NIDEK AFC-230 · 45-degree field of view · 848 by 848 pixels
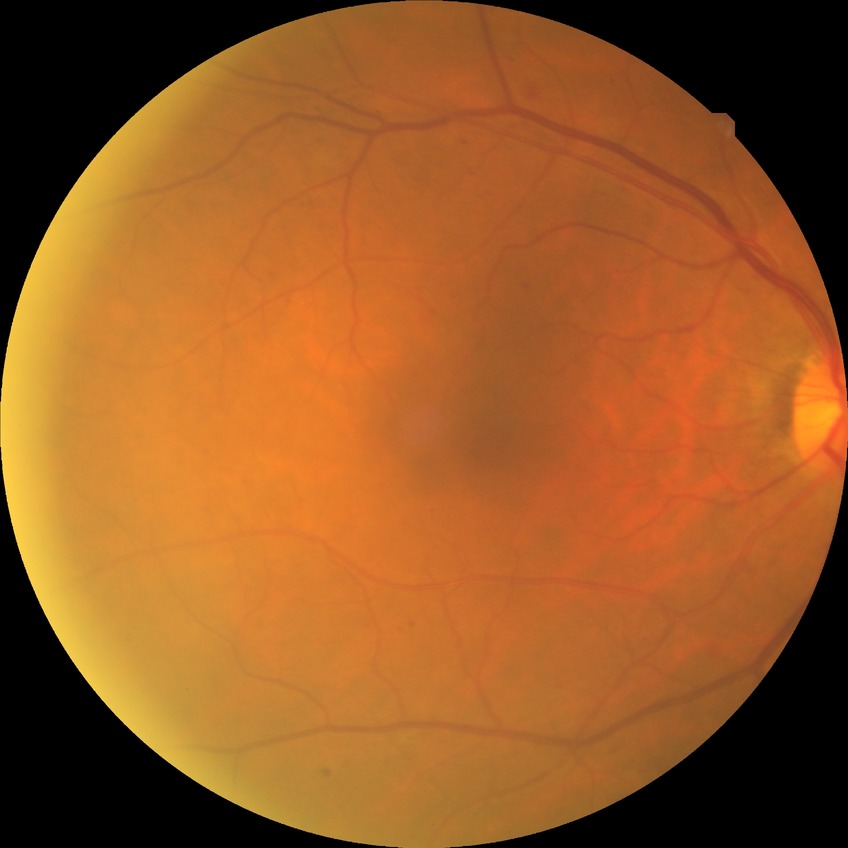
{
  "davis_grade": "SDR",
  "proliferative_class": "non-proliferative diabetic retinopathy"
}